FOV: 45 degrees. 2352x1568:
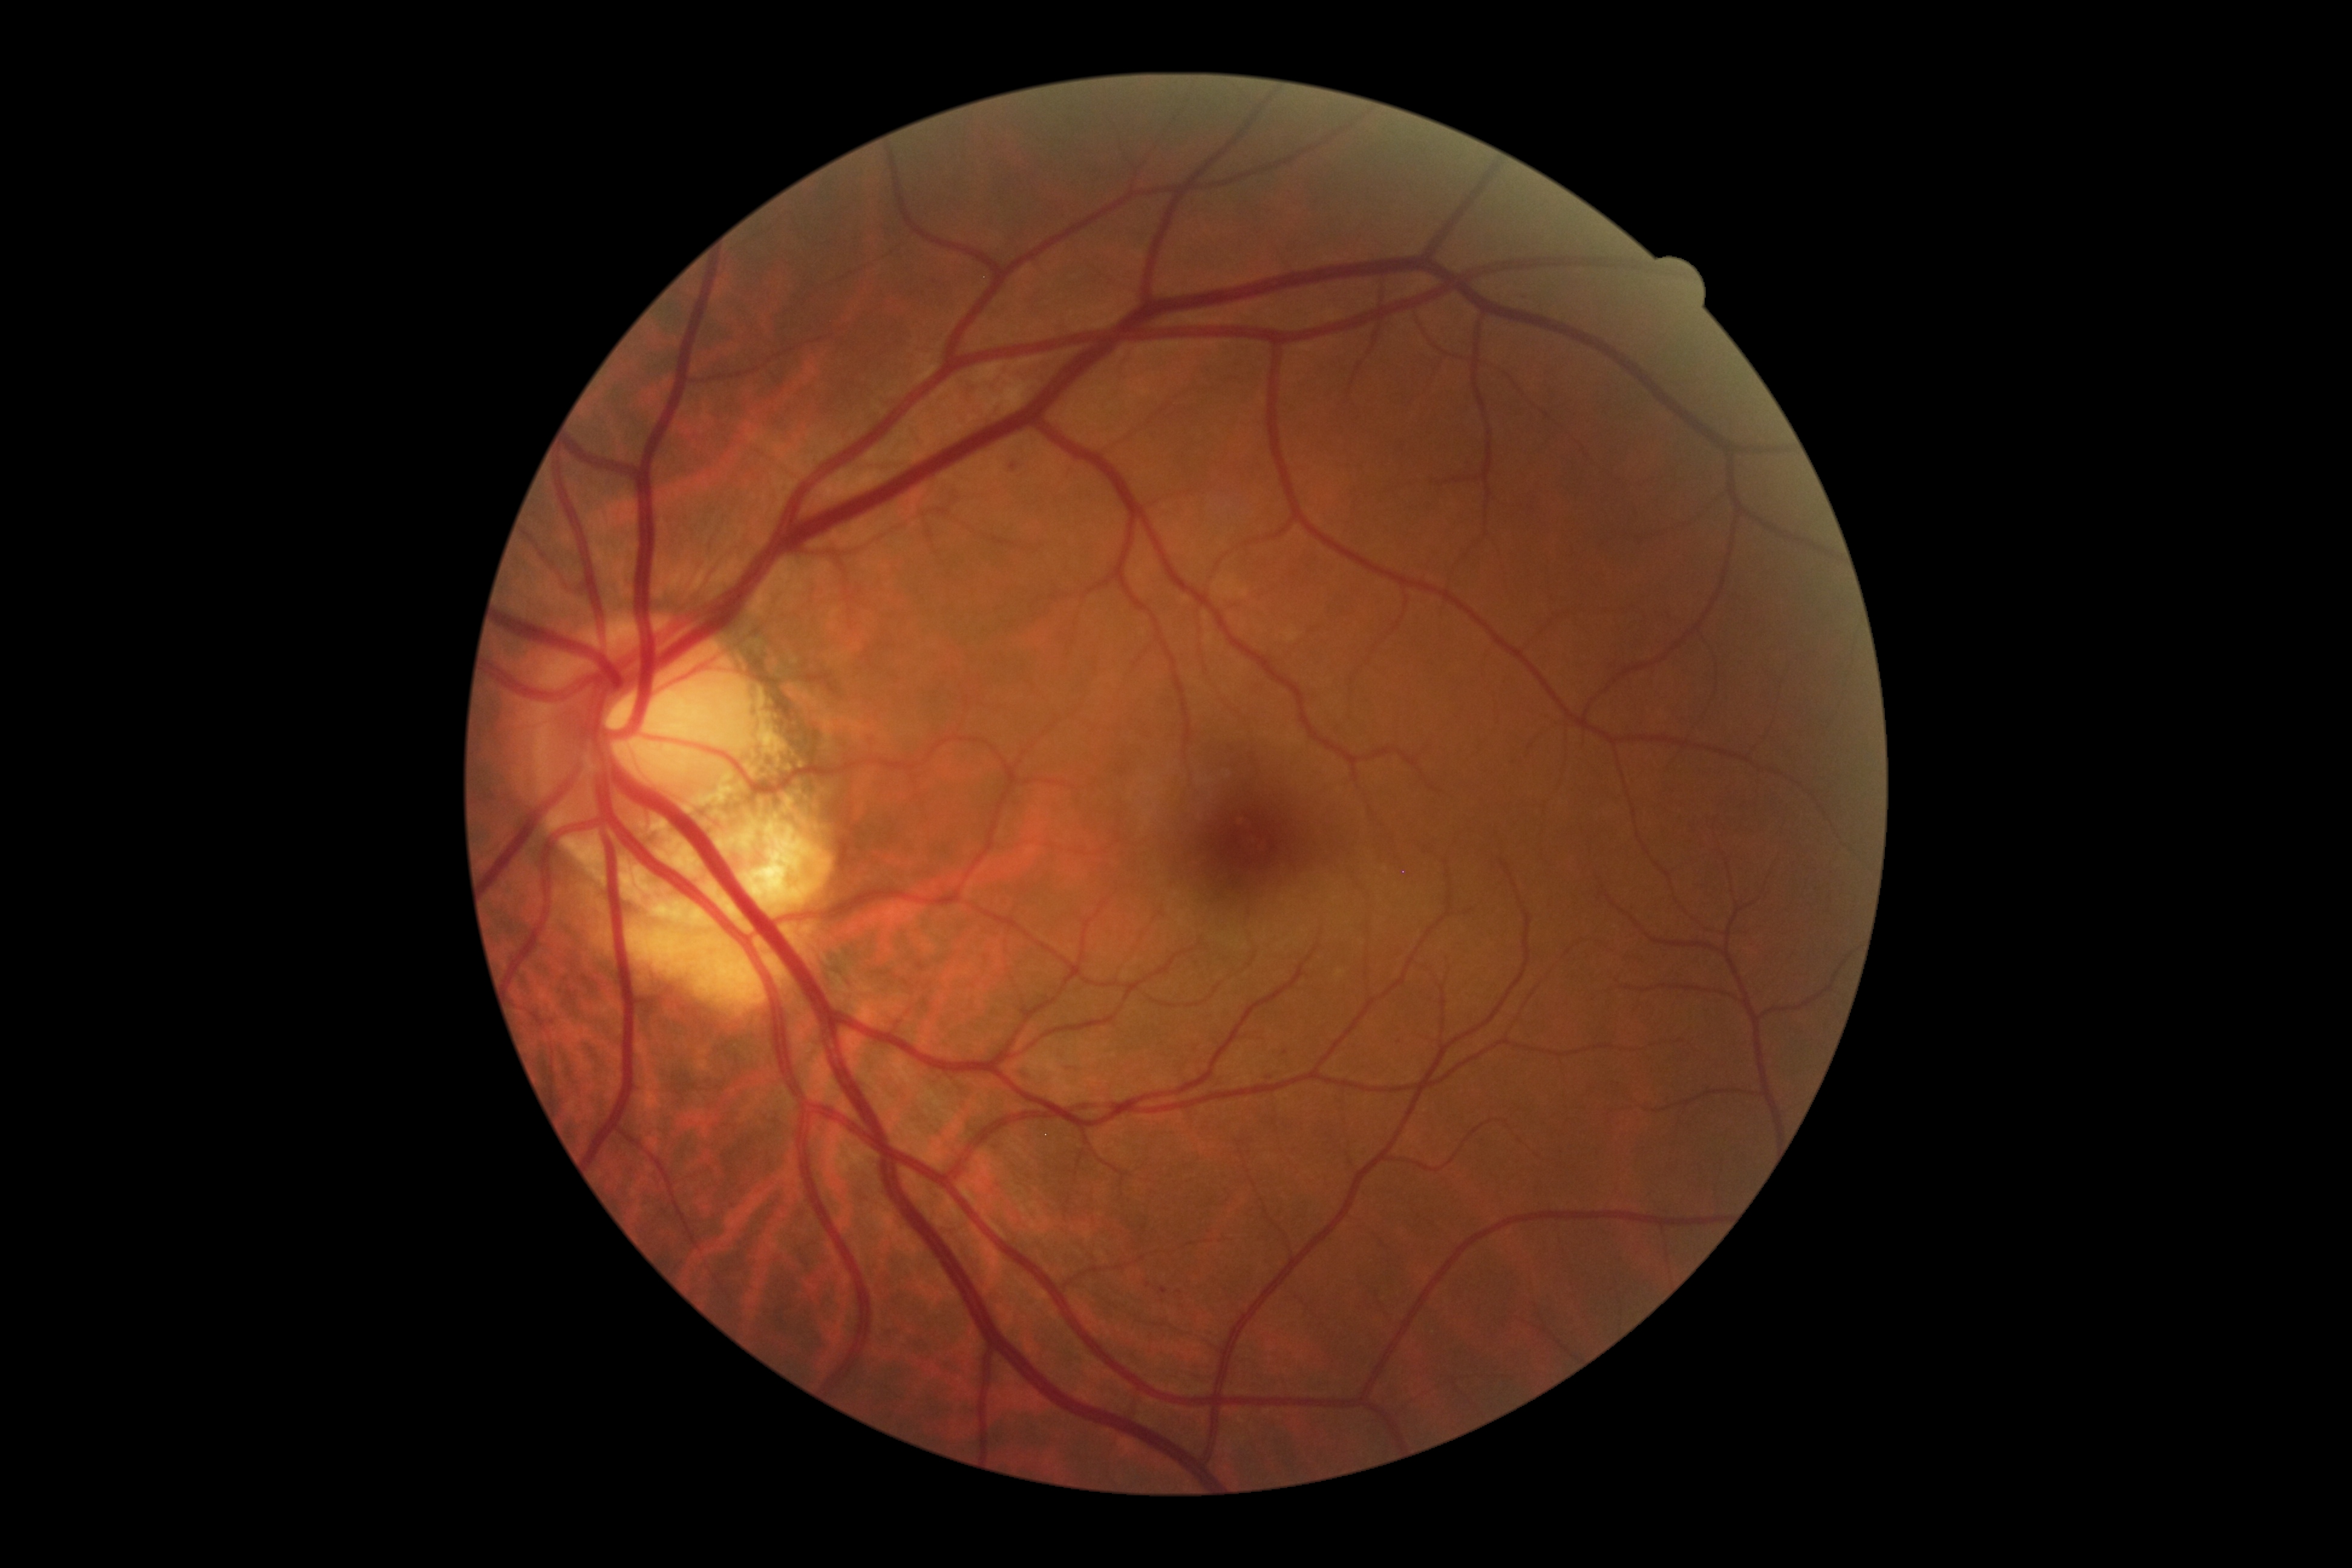
Diabetic retinopathy severity: 2/4.